Infant wide-field retinal image — 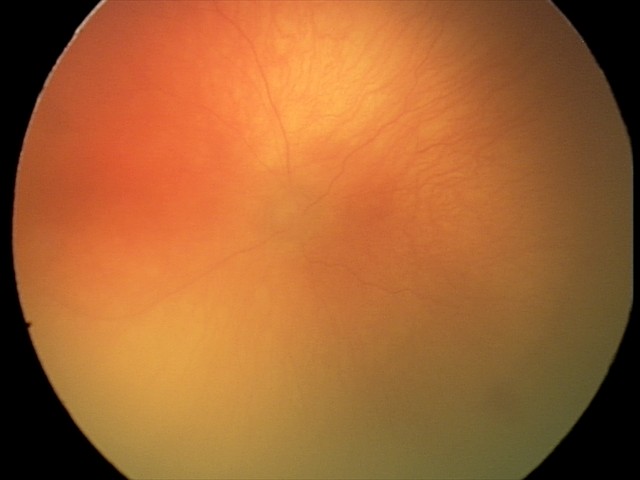
Q: What is the diagnosis from this examination?
A: aggressive retinopathy of prematurity